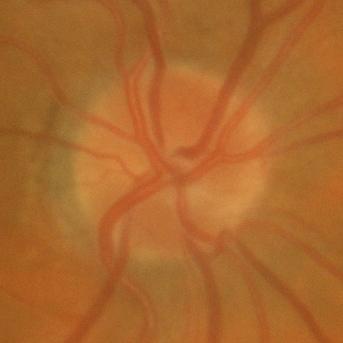

Findings consistent with no glaucomatous damage.